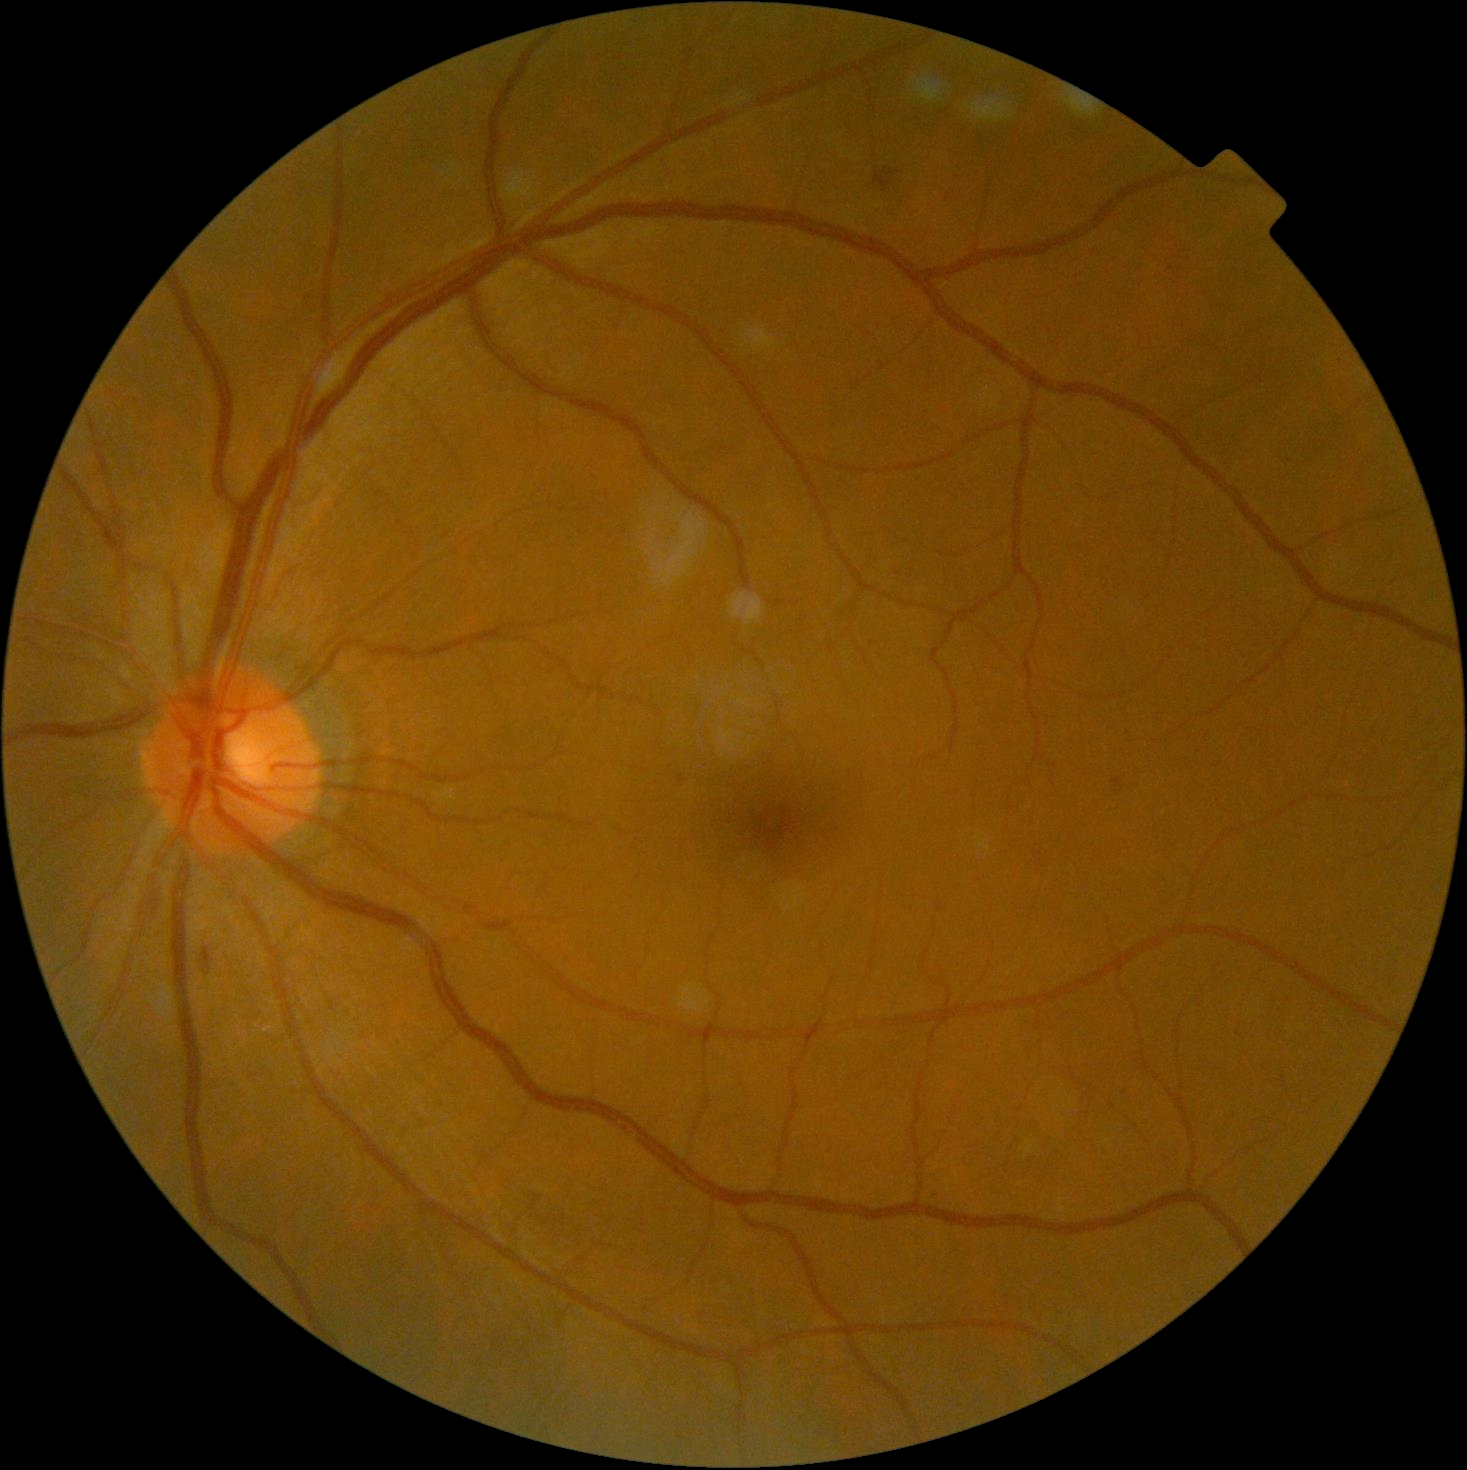 DR stage: 2.